45° field of view
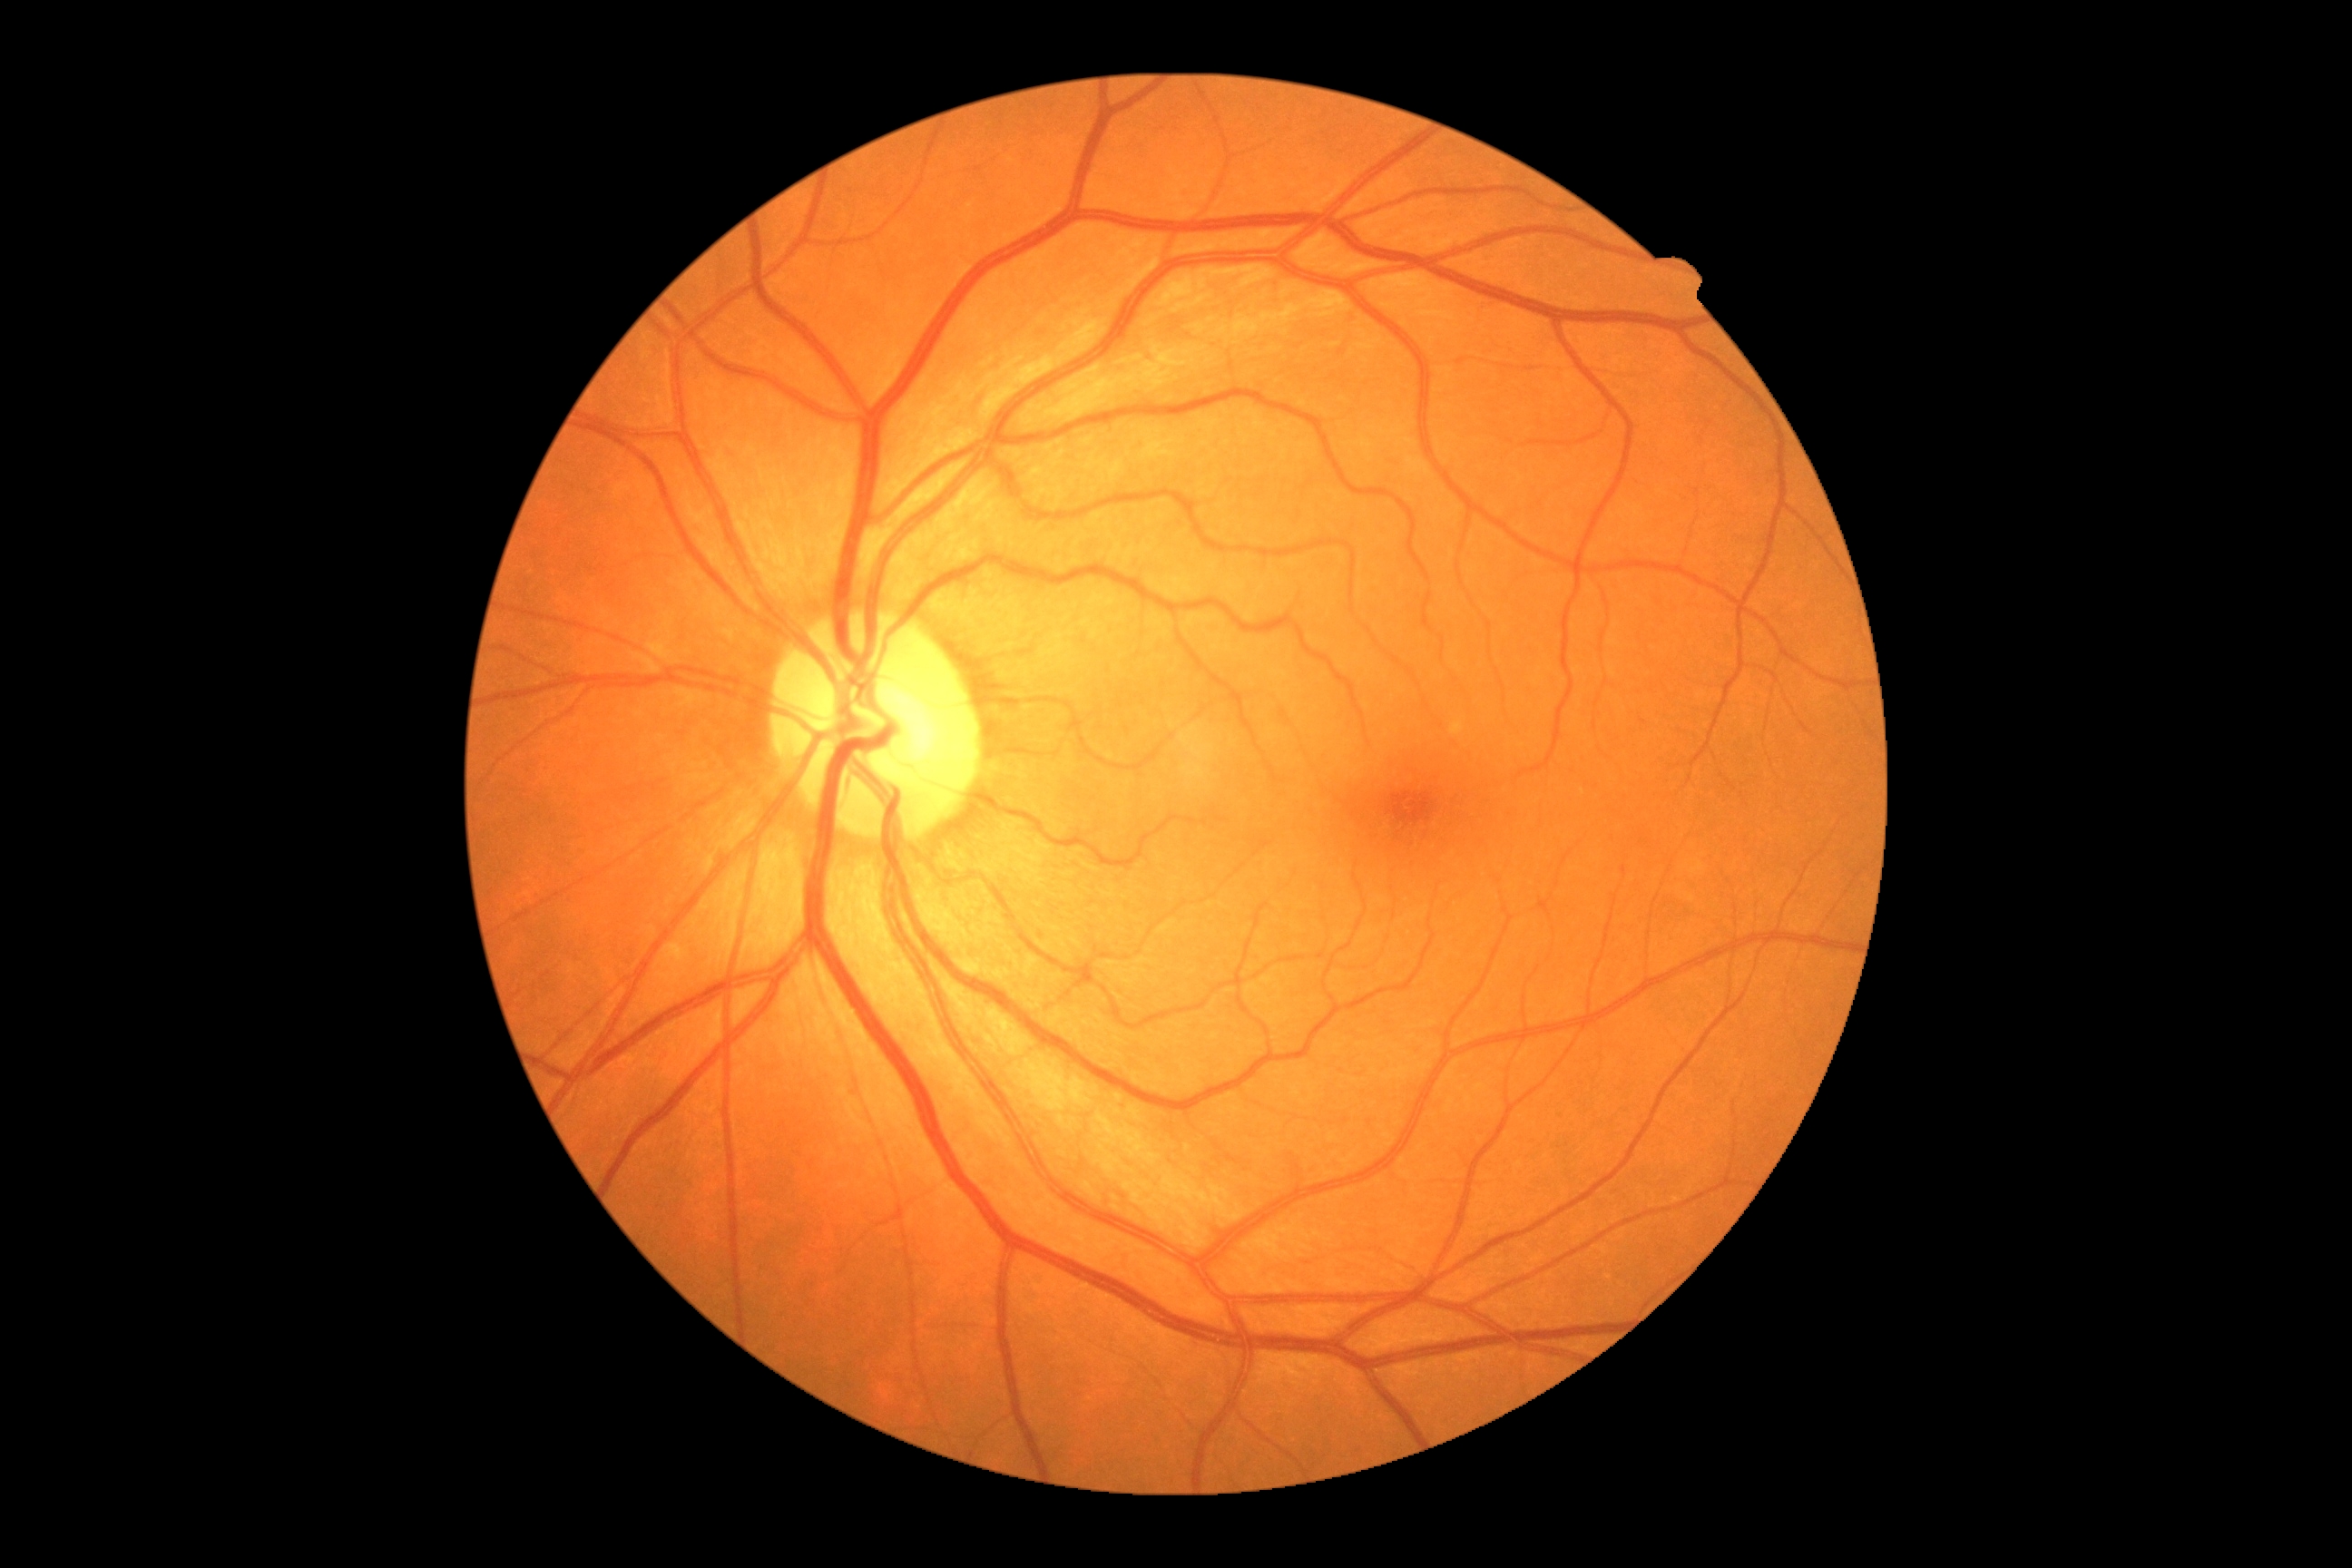

diabetic retinopathy (DR)=no apparent diabetic retinopathy (grade 0) — no visible signs of diabetic retinopathy.